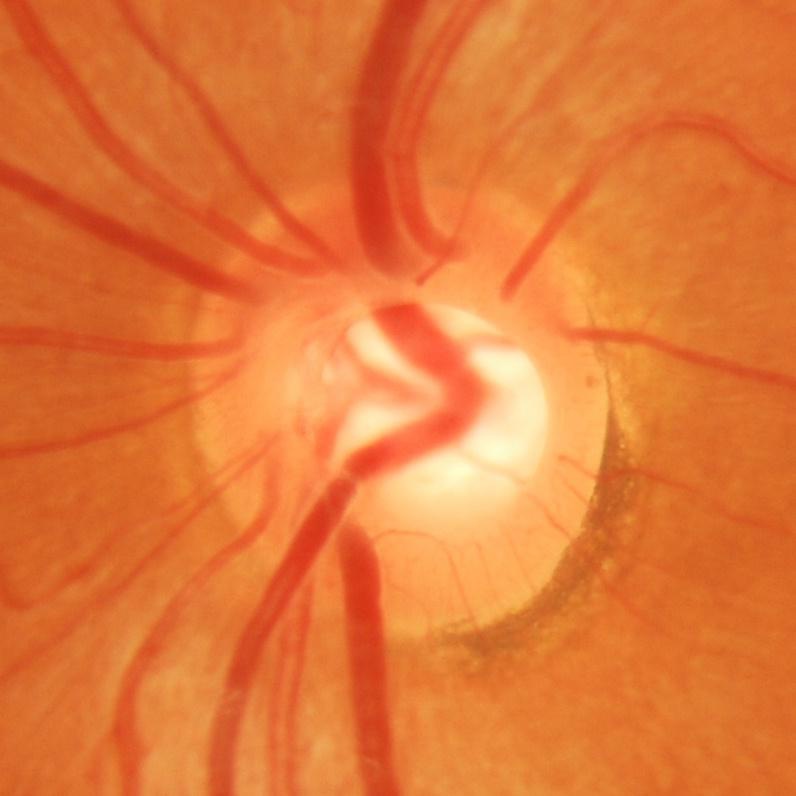

Q: Does this eye have glaucoma?
A: Yes — glaucomatous changes.